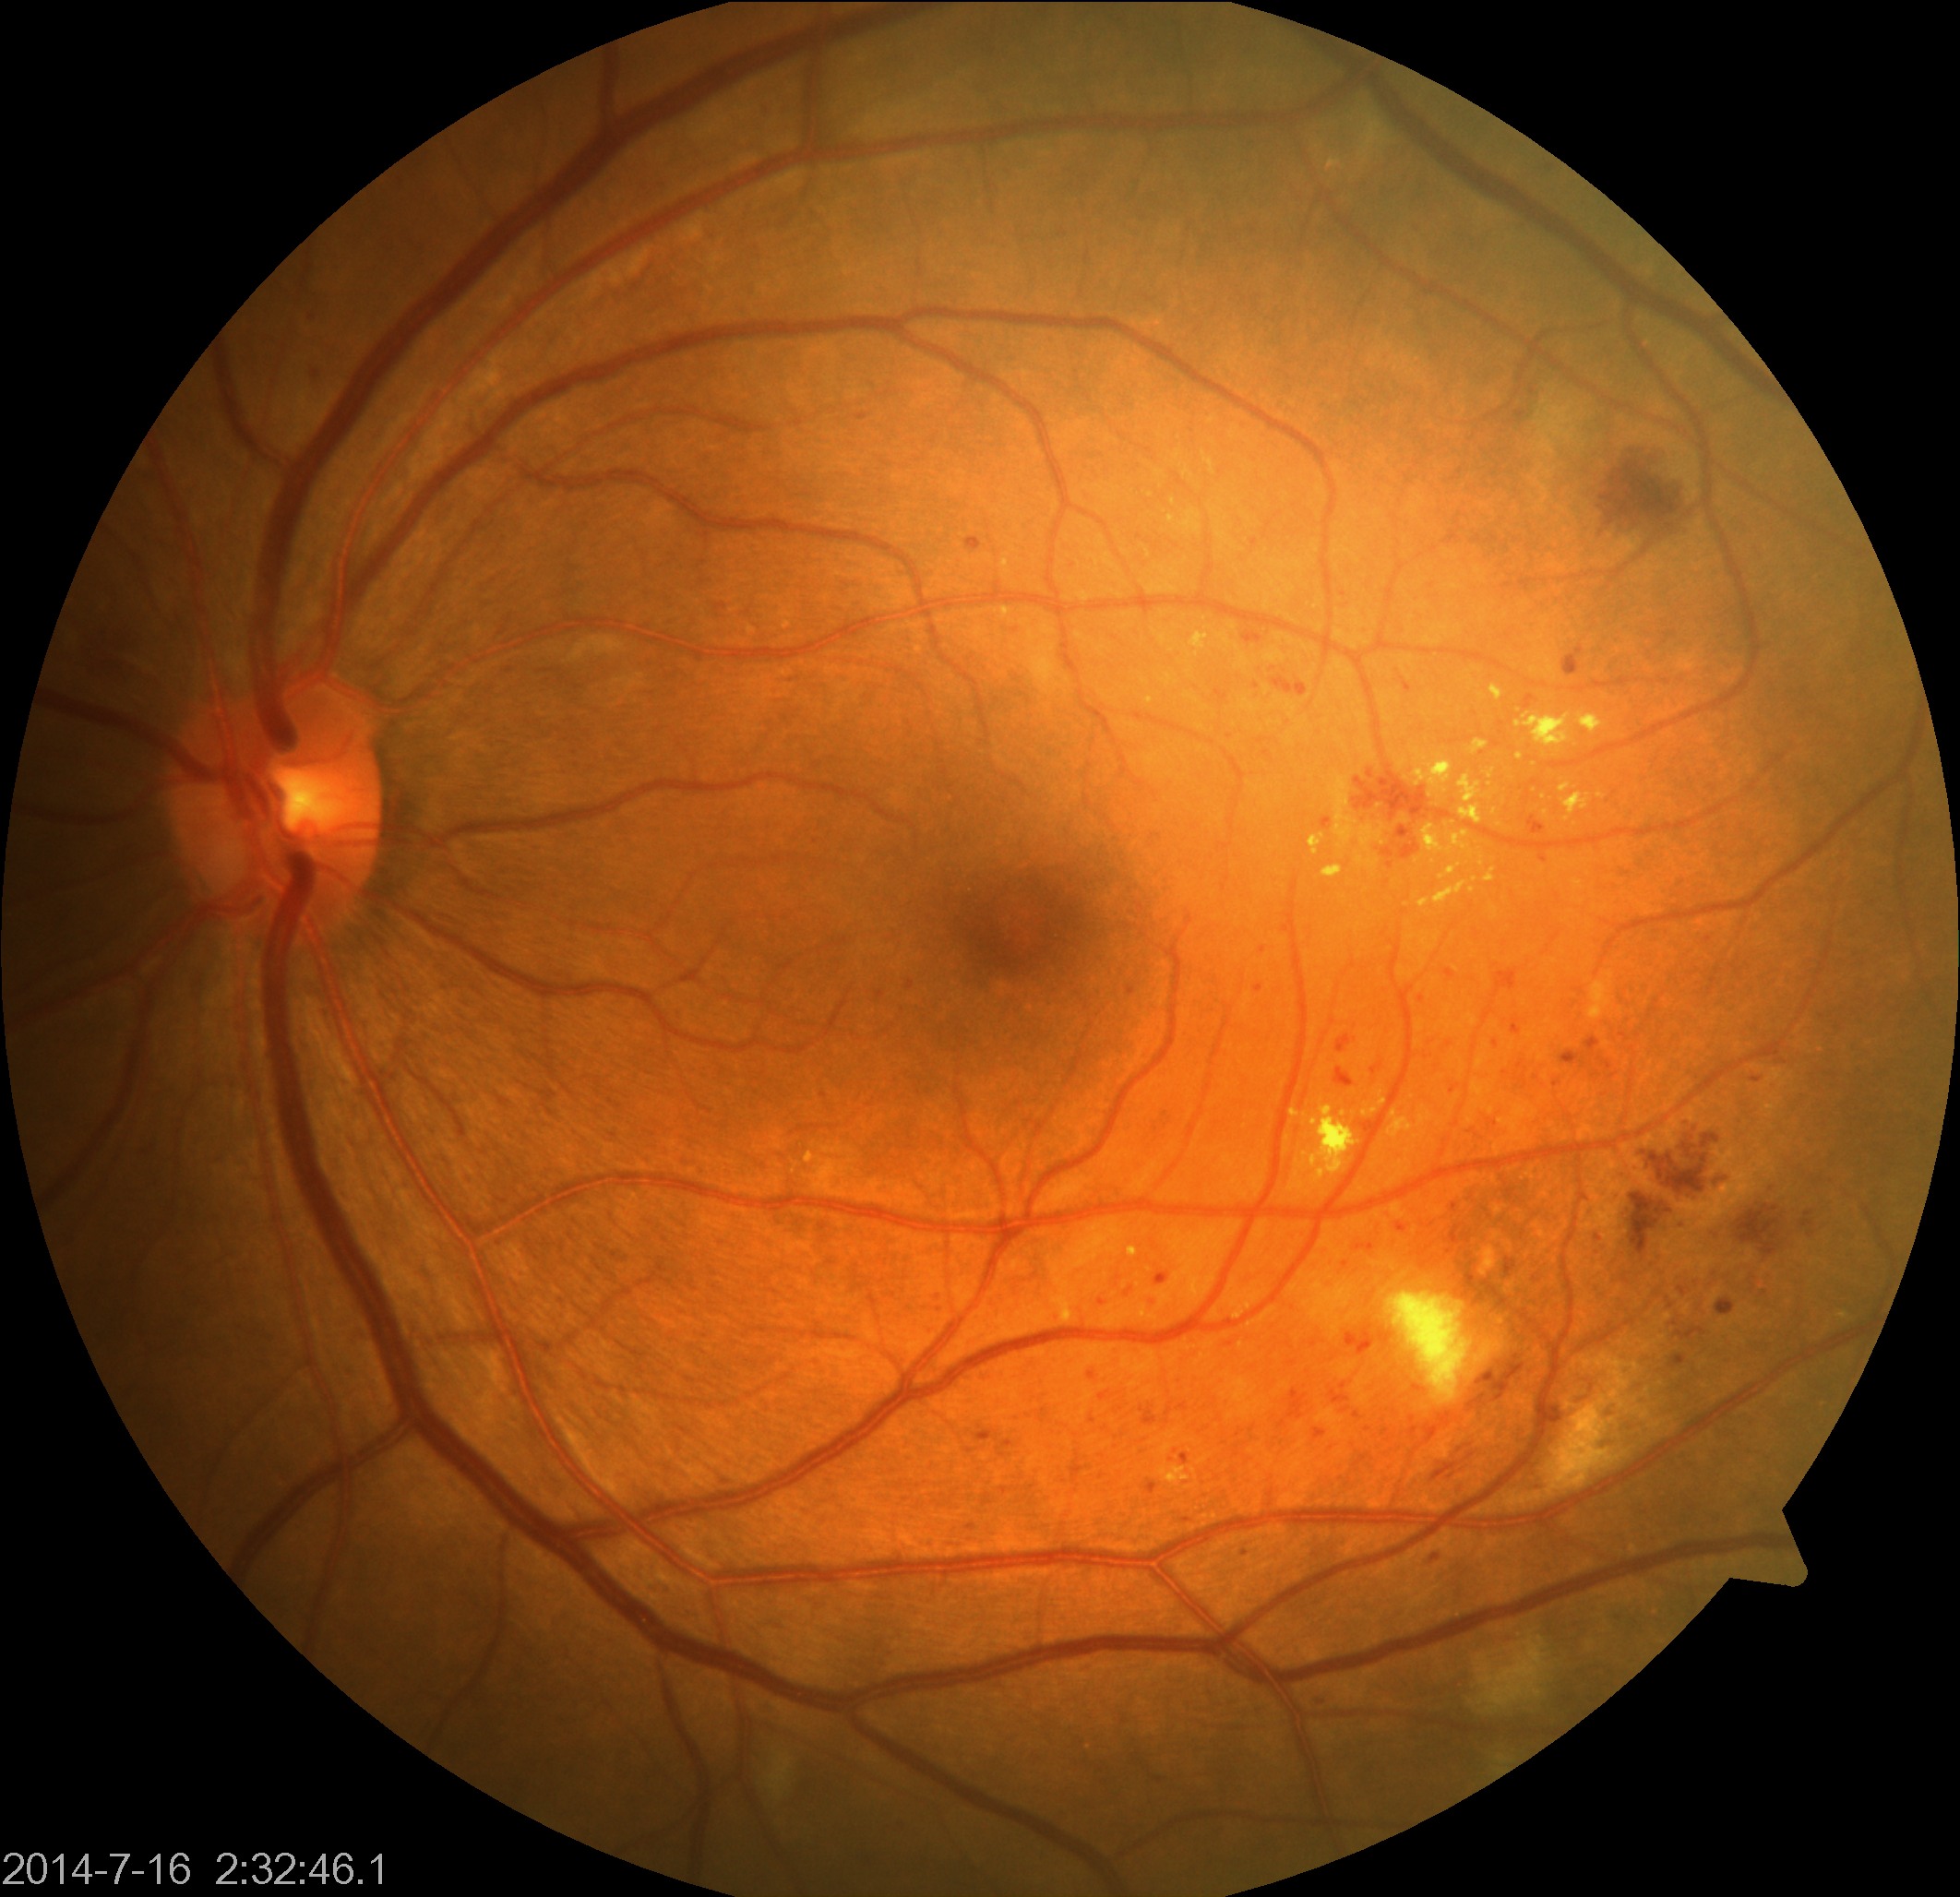

The image shows moderate non-proliferative diabetic retinopathy.